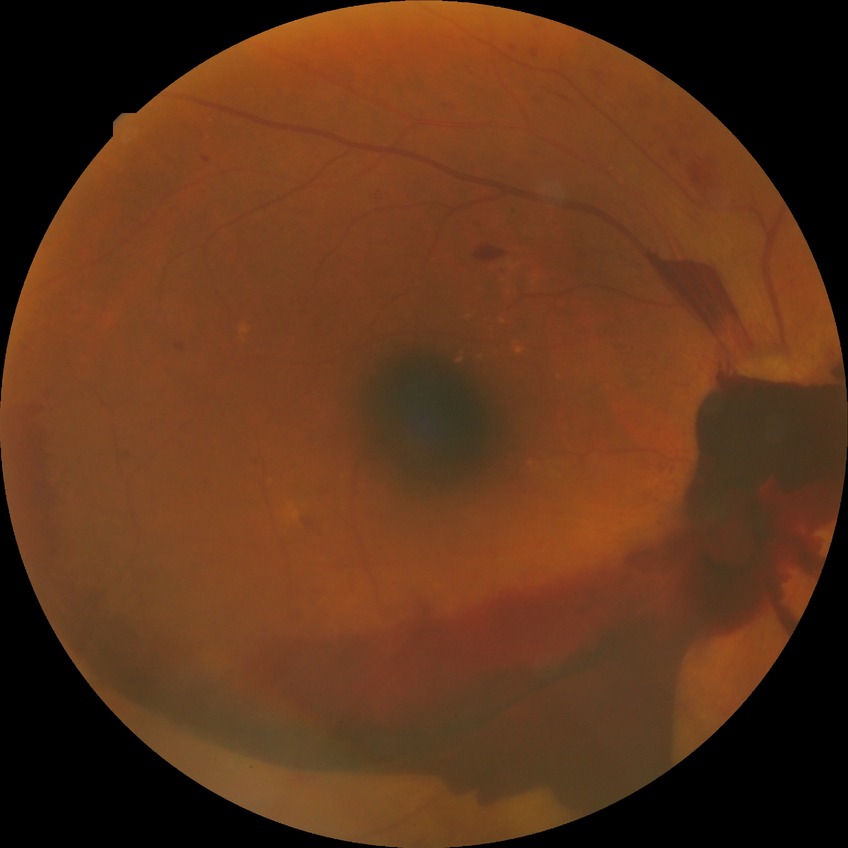 Diabetic retinopathy grade is proliferative diabetic retinopathy.